Wide-field fundus image from infant ROP screening · camera: Phoenix ICON (100° FOV) · image size 1240x1240: 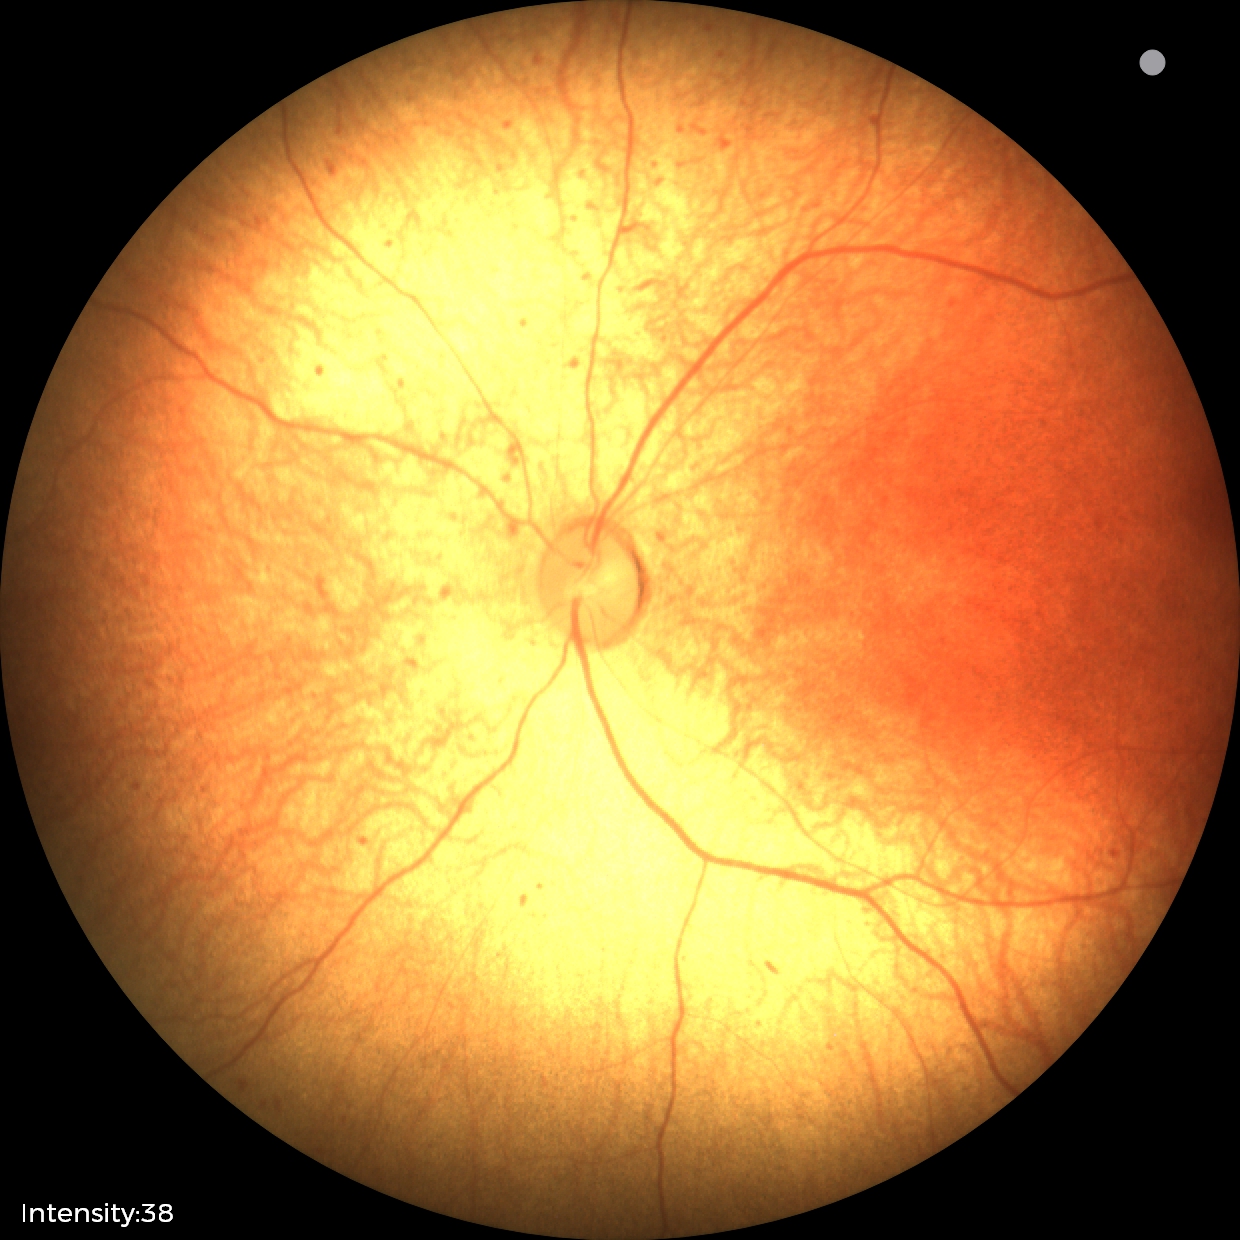 Q: What was the screening finding?
A: status post retinopathy of prematurity — retinal appearance after treated retinopathy of prematurity
Q: What is the plus-form classification?
A: no plus disease